45° field of view · 2352x1568:
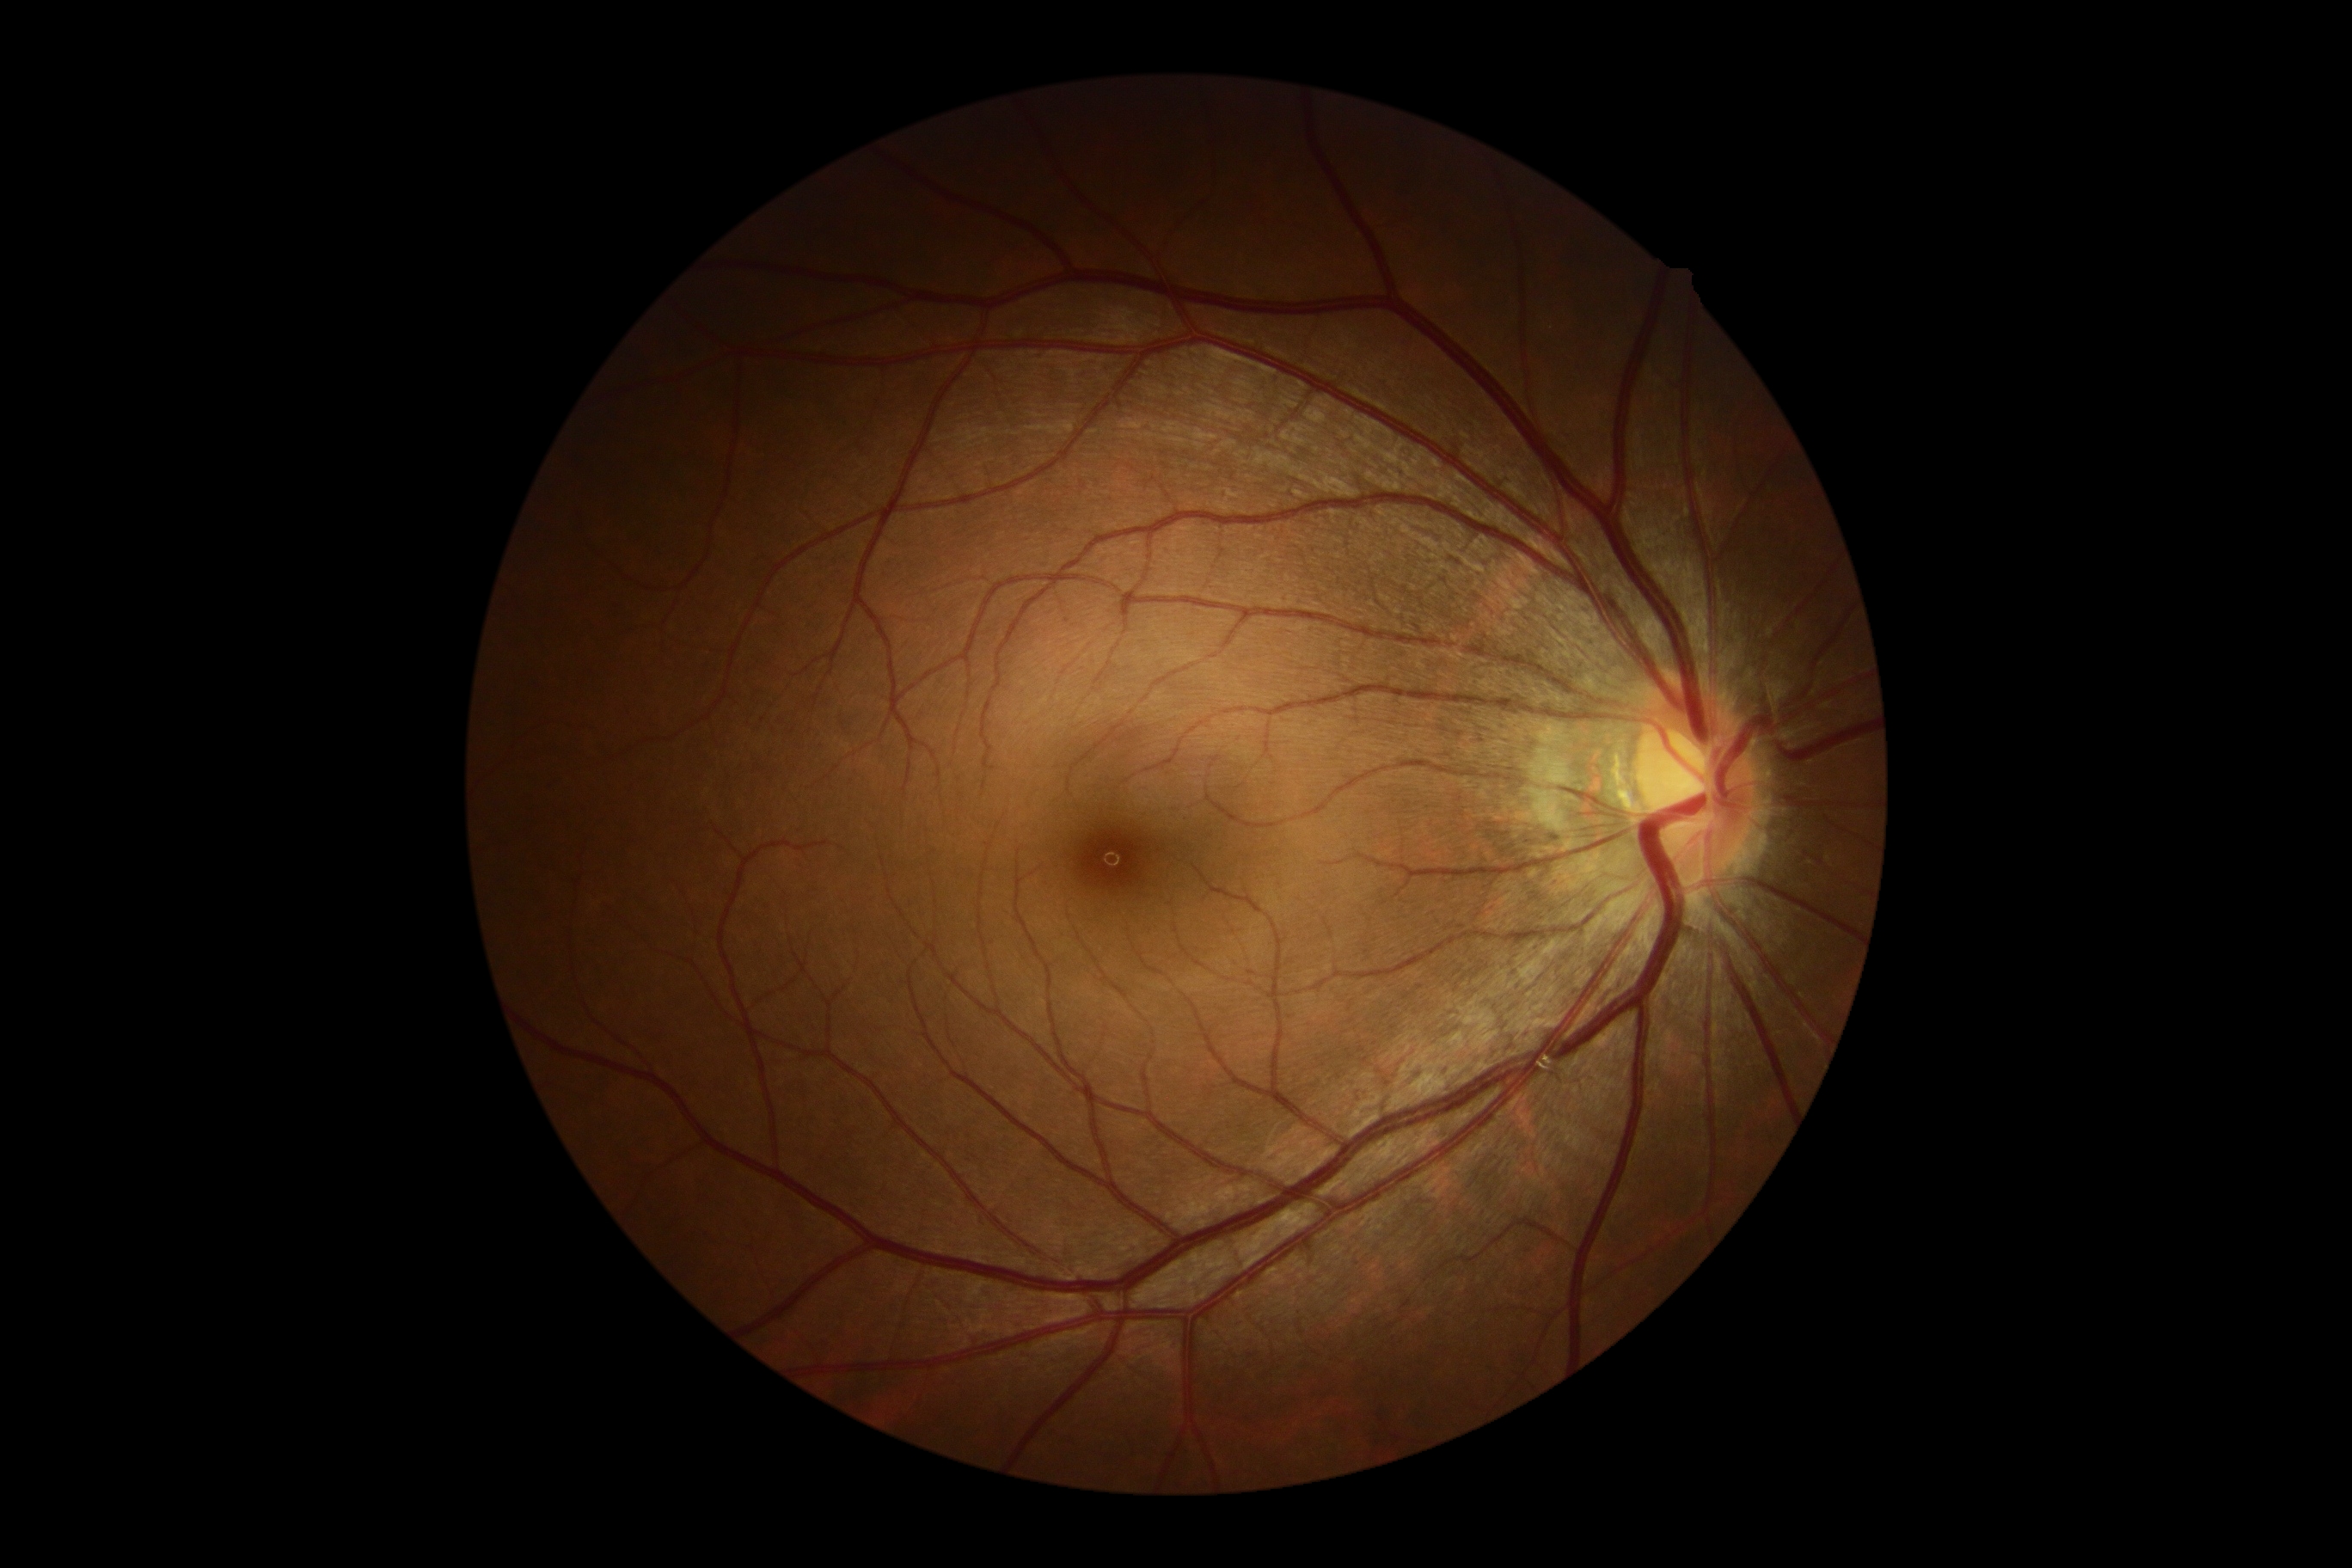
diabetic retinopathy grade = no apparent diabetic retinopathy (0) — no visible signs of diabetic retinopathy; DR impression = no DR findings.